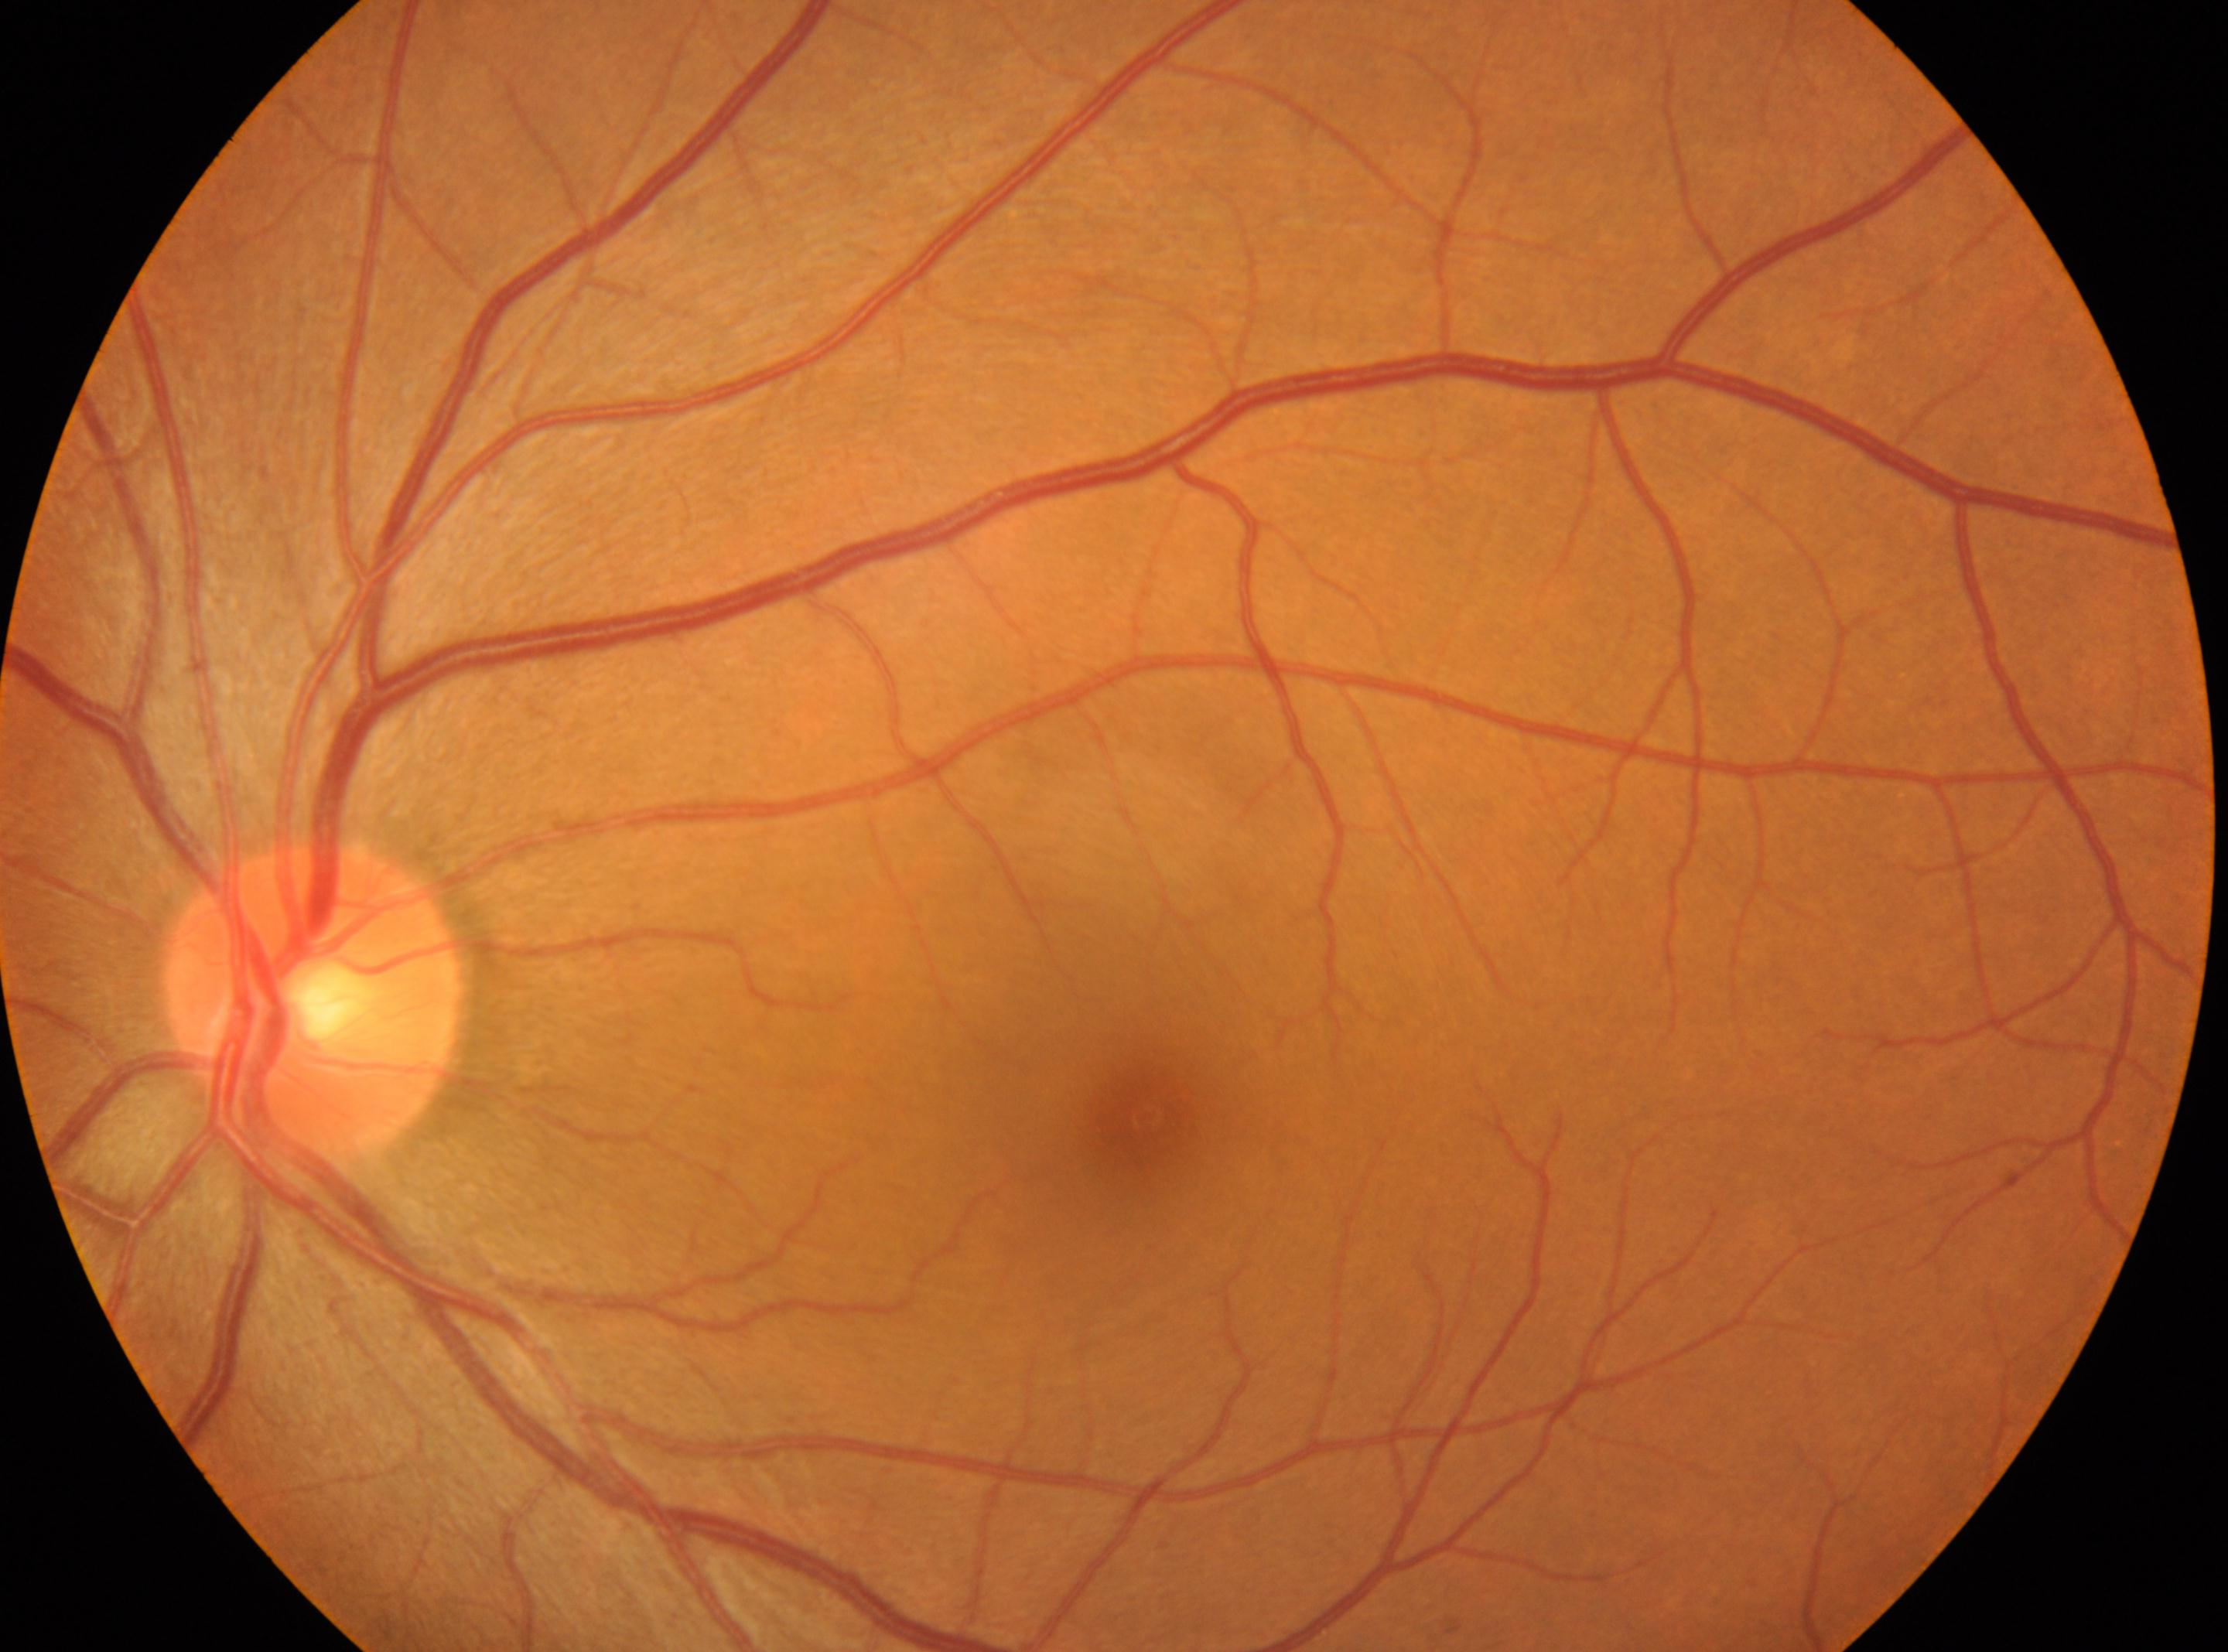 {"fovea": "1142px, 1117px", "dr_grade": "0 (no apparent retinopathy)", "dr_impression": "No diabetic retinal disease findings", "optic_disc": "311px, 1005px", "eye": "left eye"}